Camera: NIDEK AFC-230 — 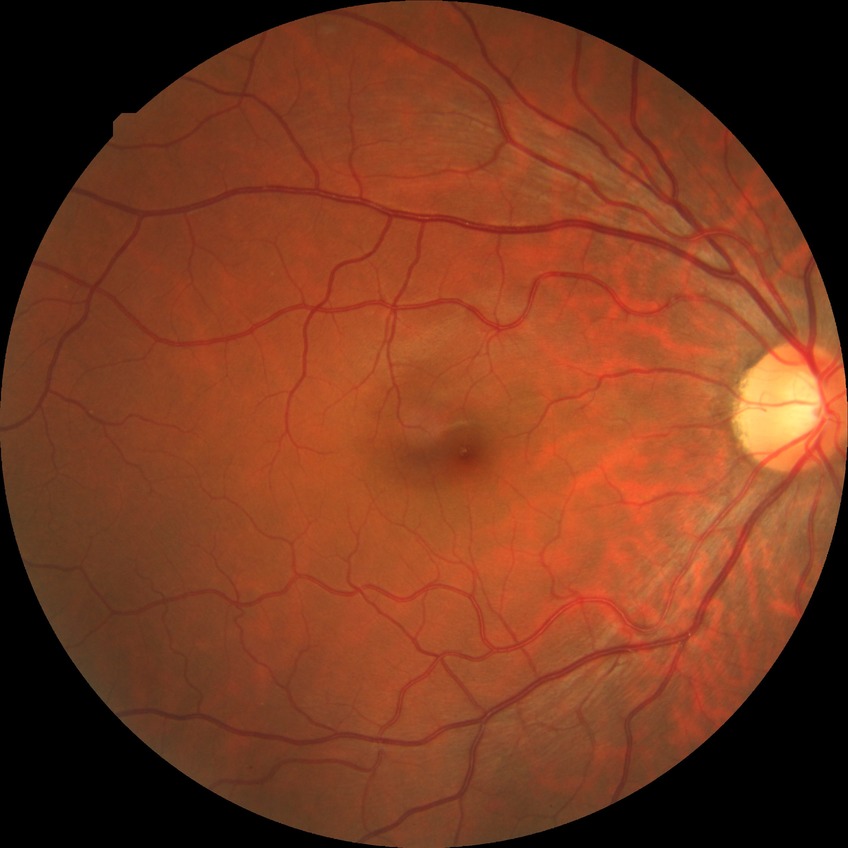 Diabetic retinopathy grade: no diabetic retinopathy.